Retinal fundus photograph · perimetry mean defect: 1.05 dB · non-mydriatic · 50-year-old patient · axial length (AL): 24.3 mm · Topcon TRC-NW400 · 30° field of view: 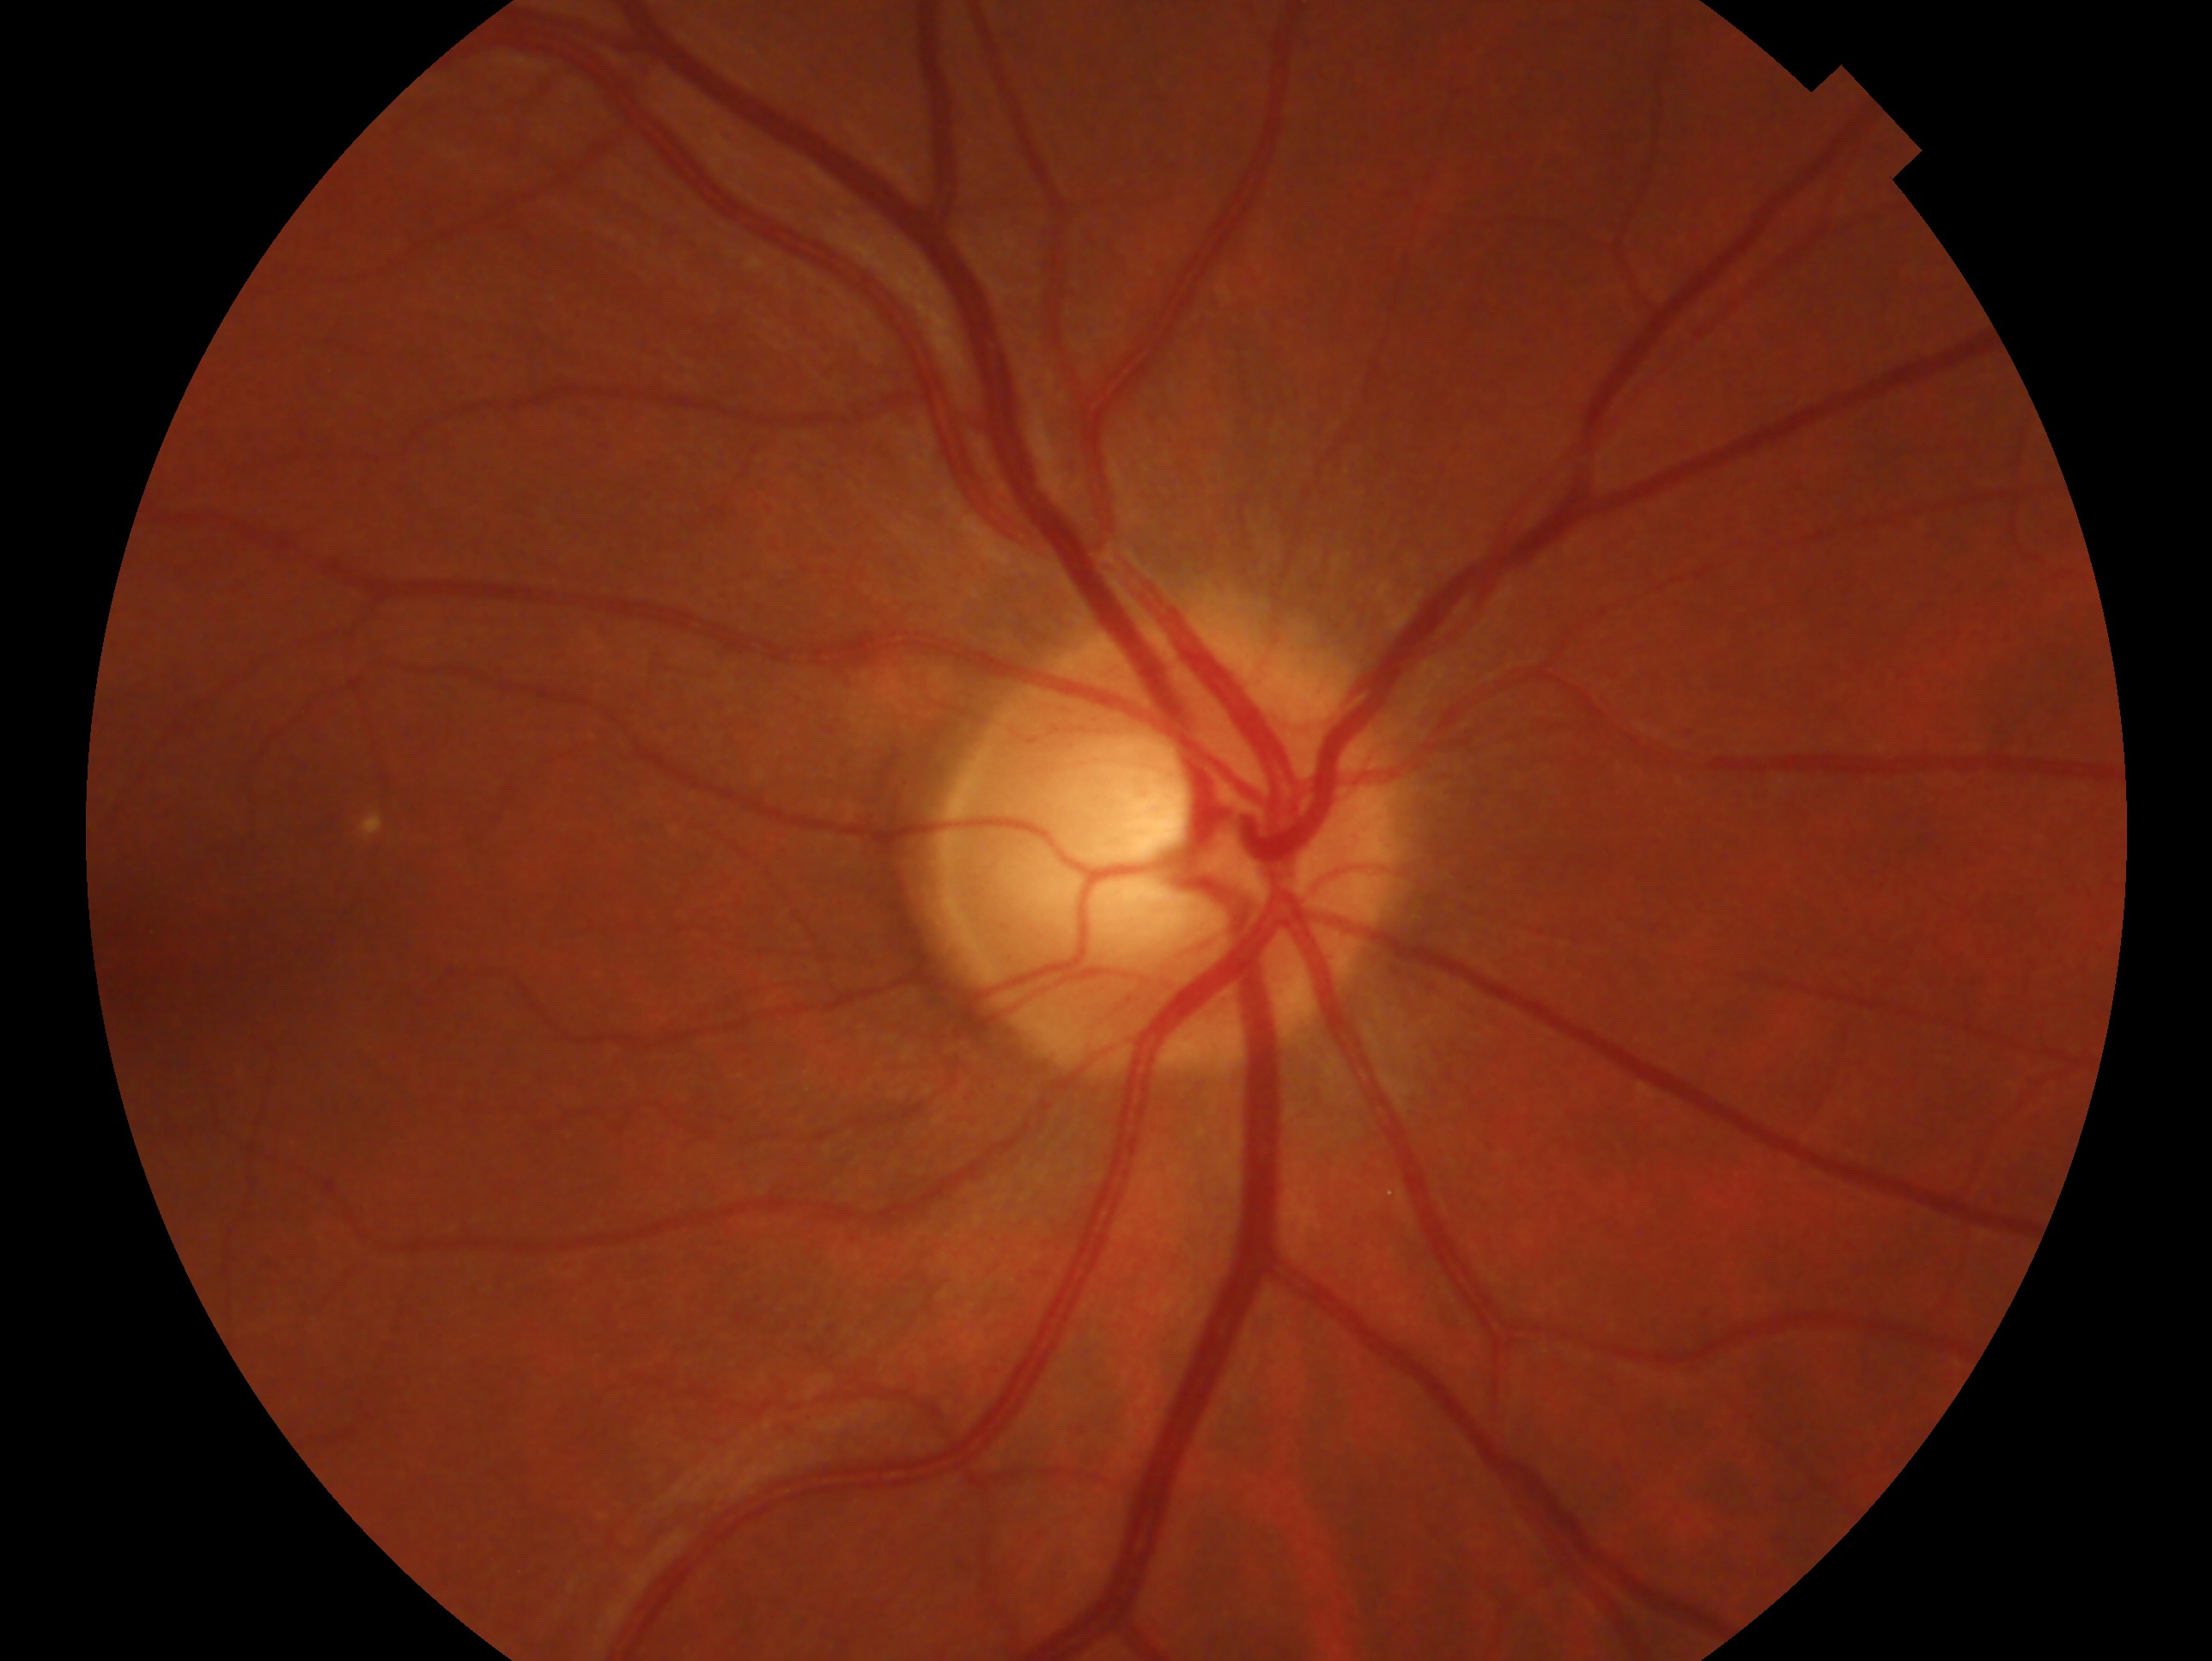 This is the OD.
Impression — glaucoma suspect.